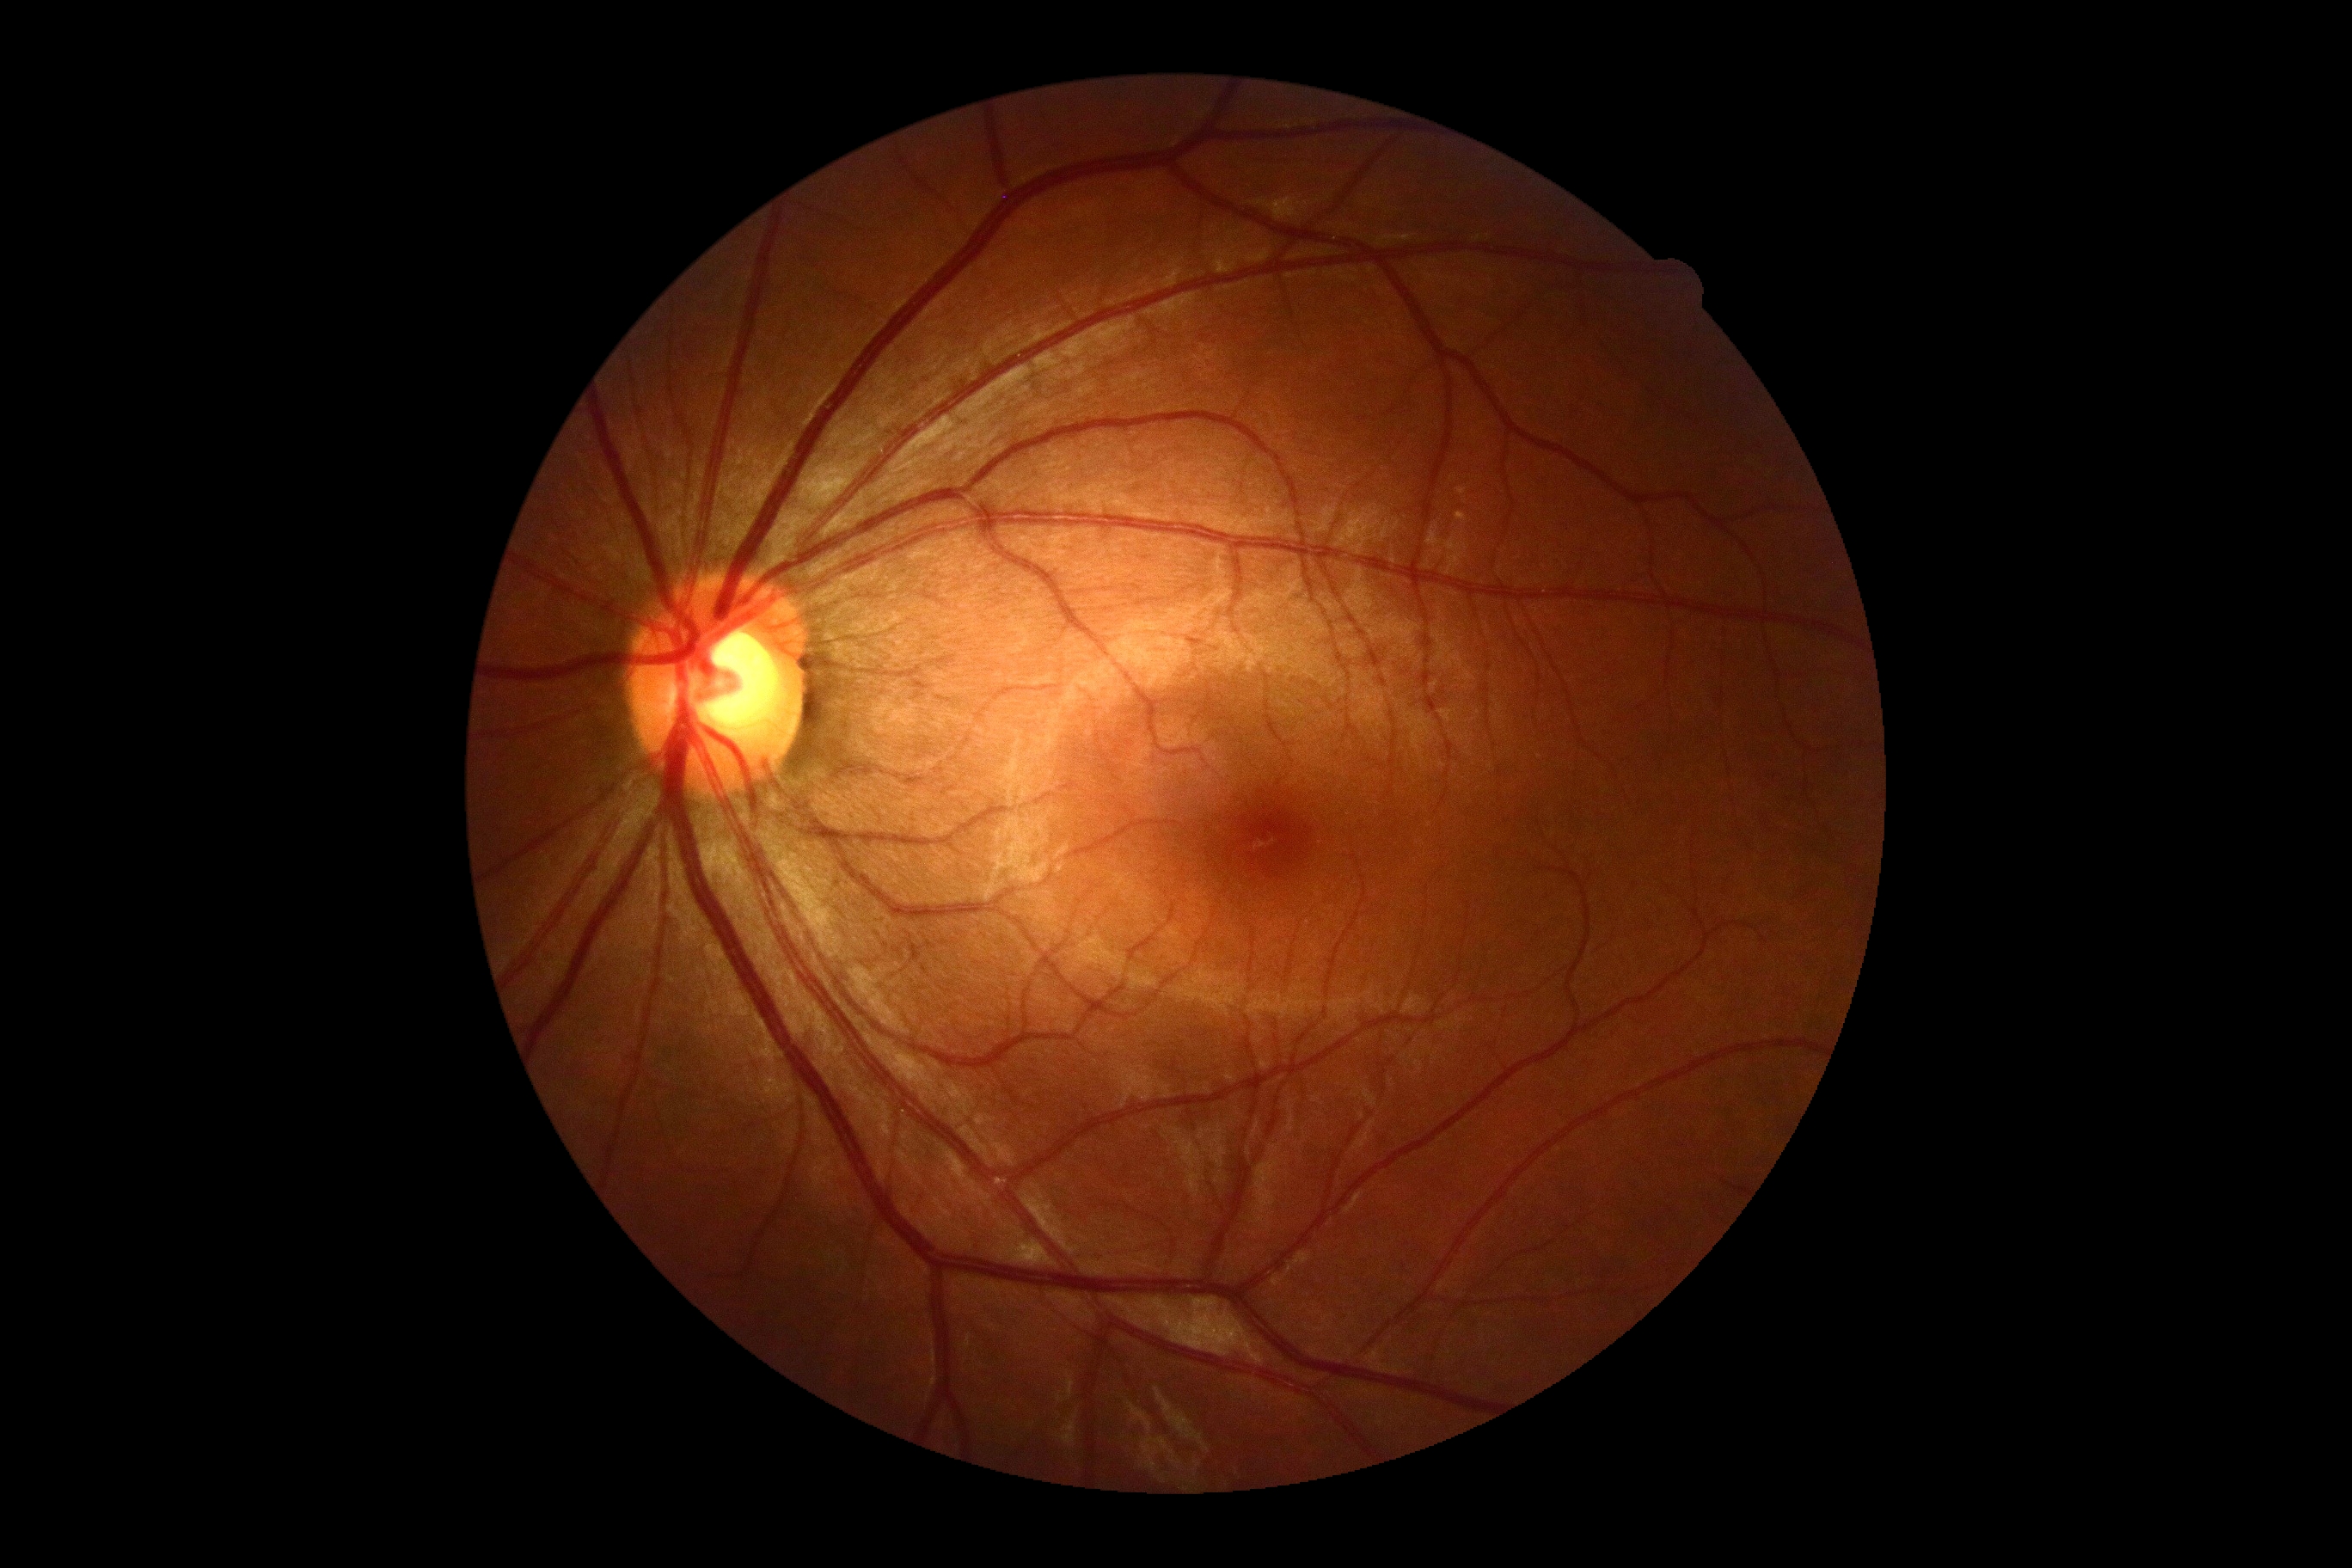
DR grade: 0 (no apparent retinopathy). No DR findings.